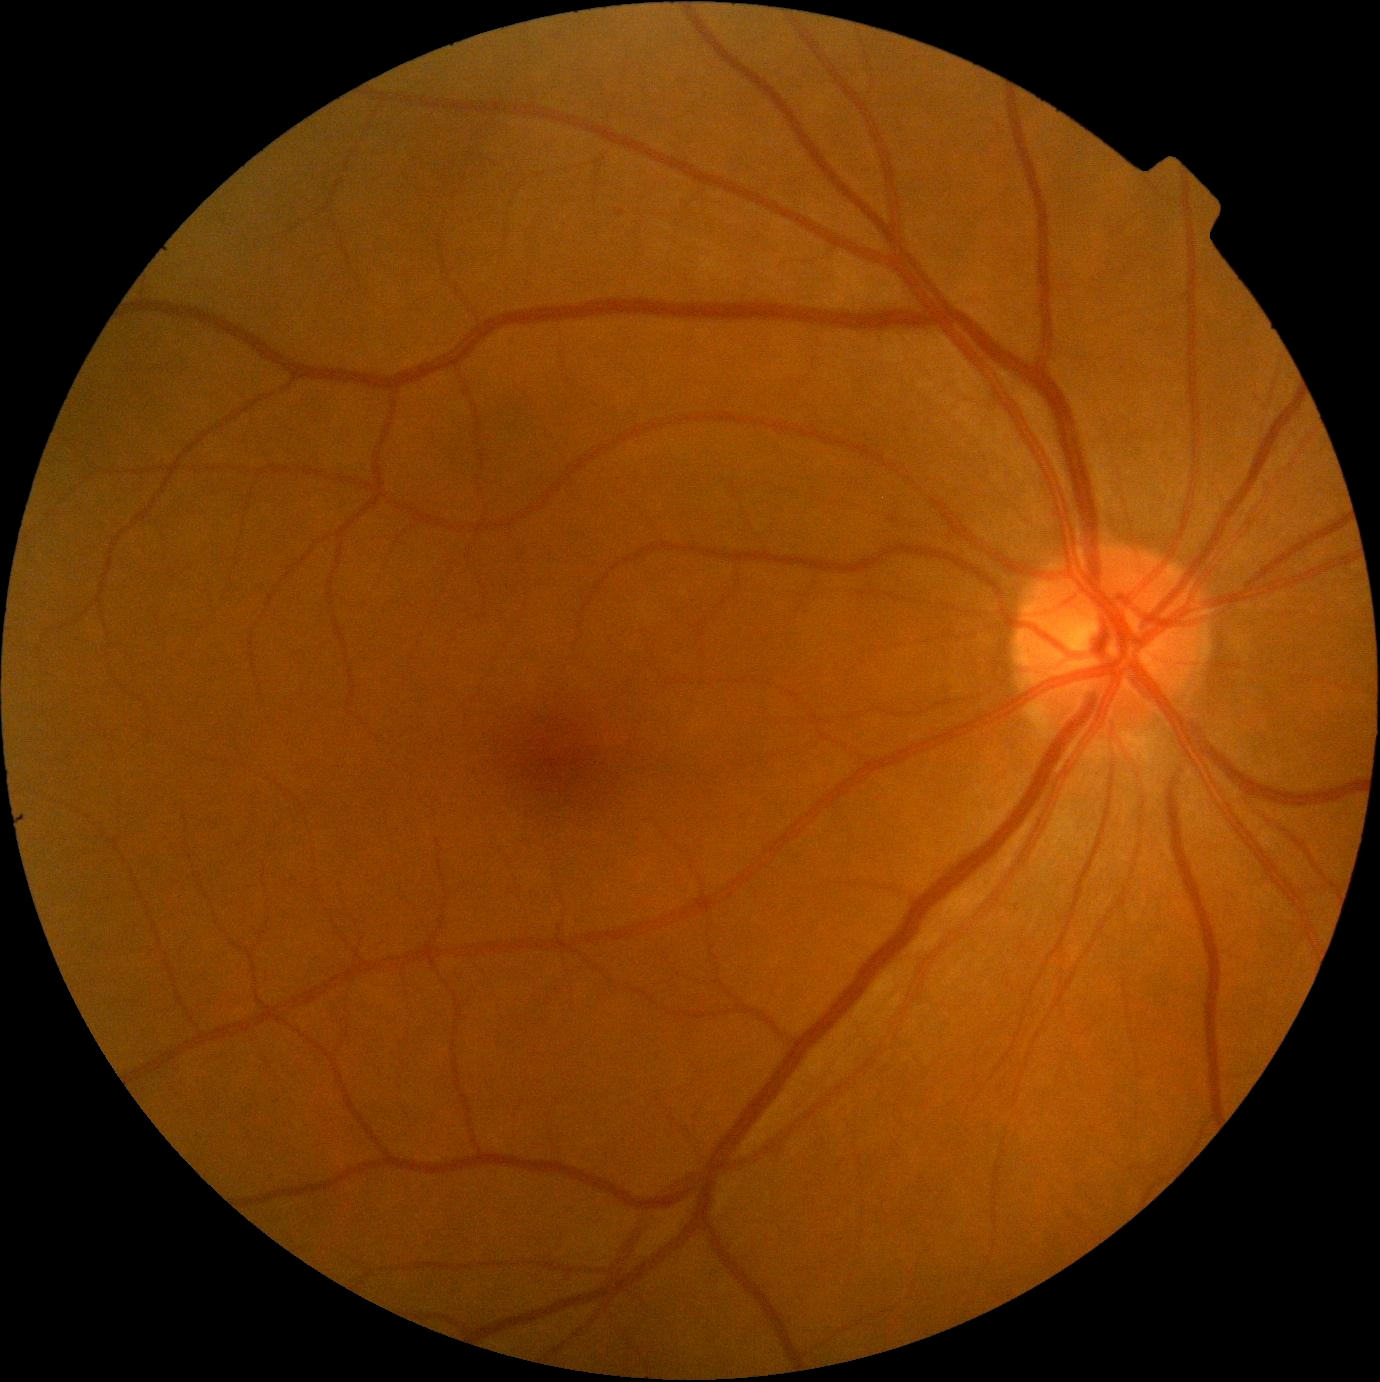

DR grade is 0.
No diabetic retinal disease findings.